Davis DR grading — 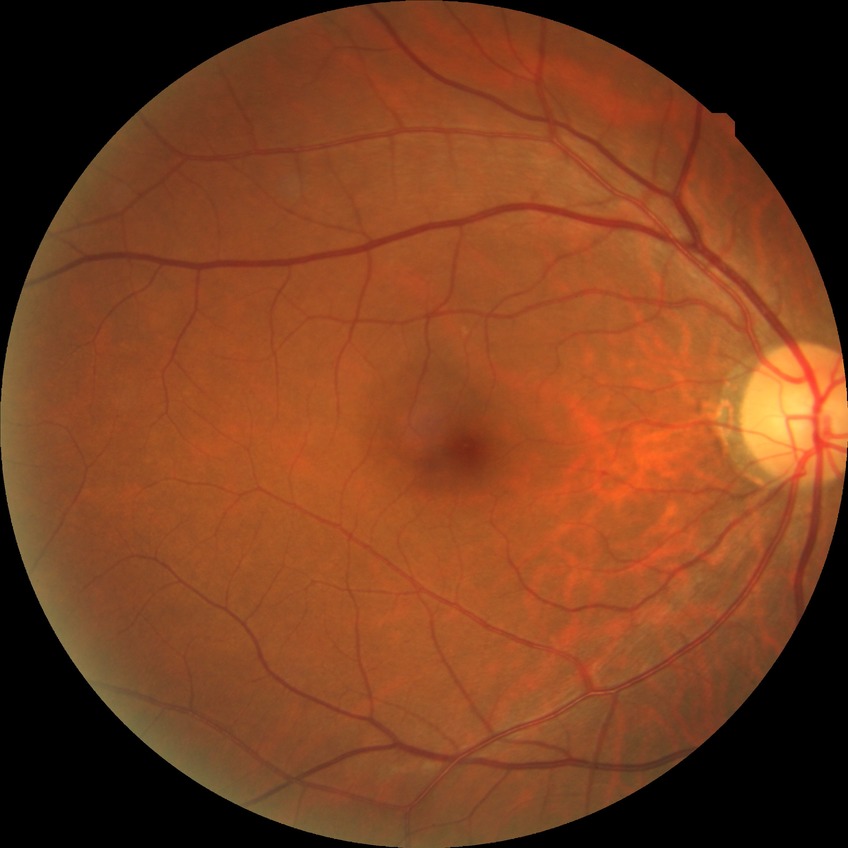
DR severity: NDR.